Modified Davis classification — 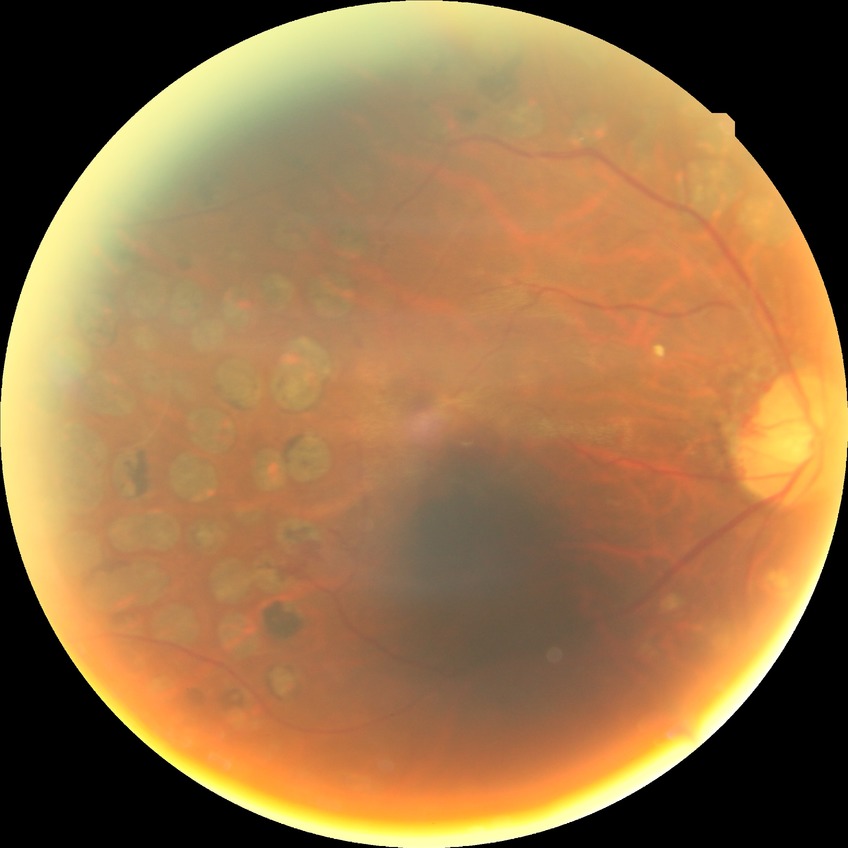

Davis stage is PDR.